1659x2212px. Remidio FOP fundus camera: 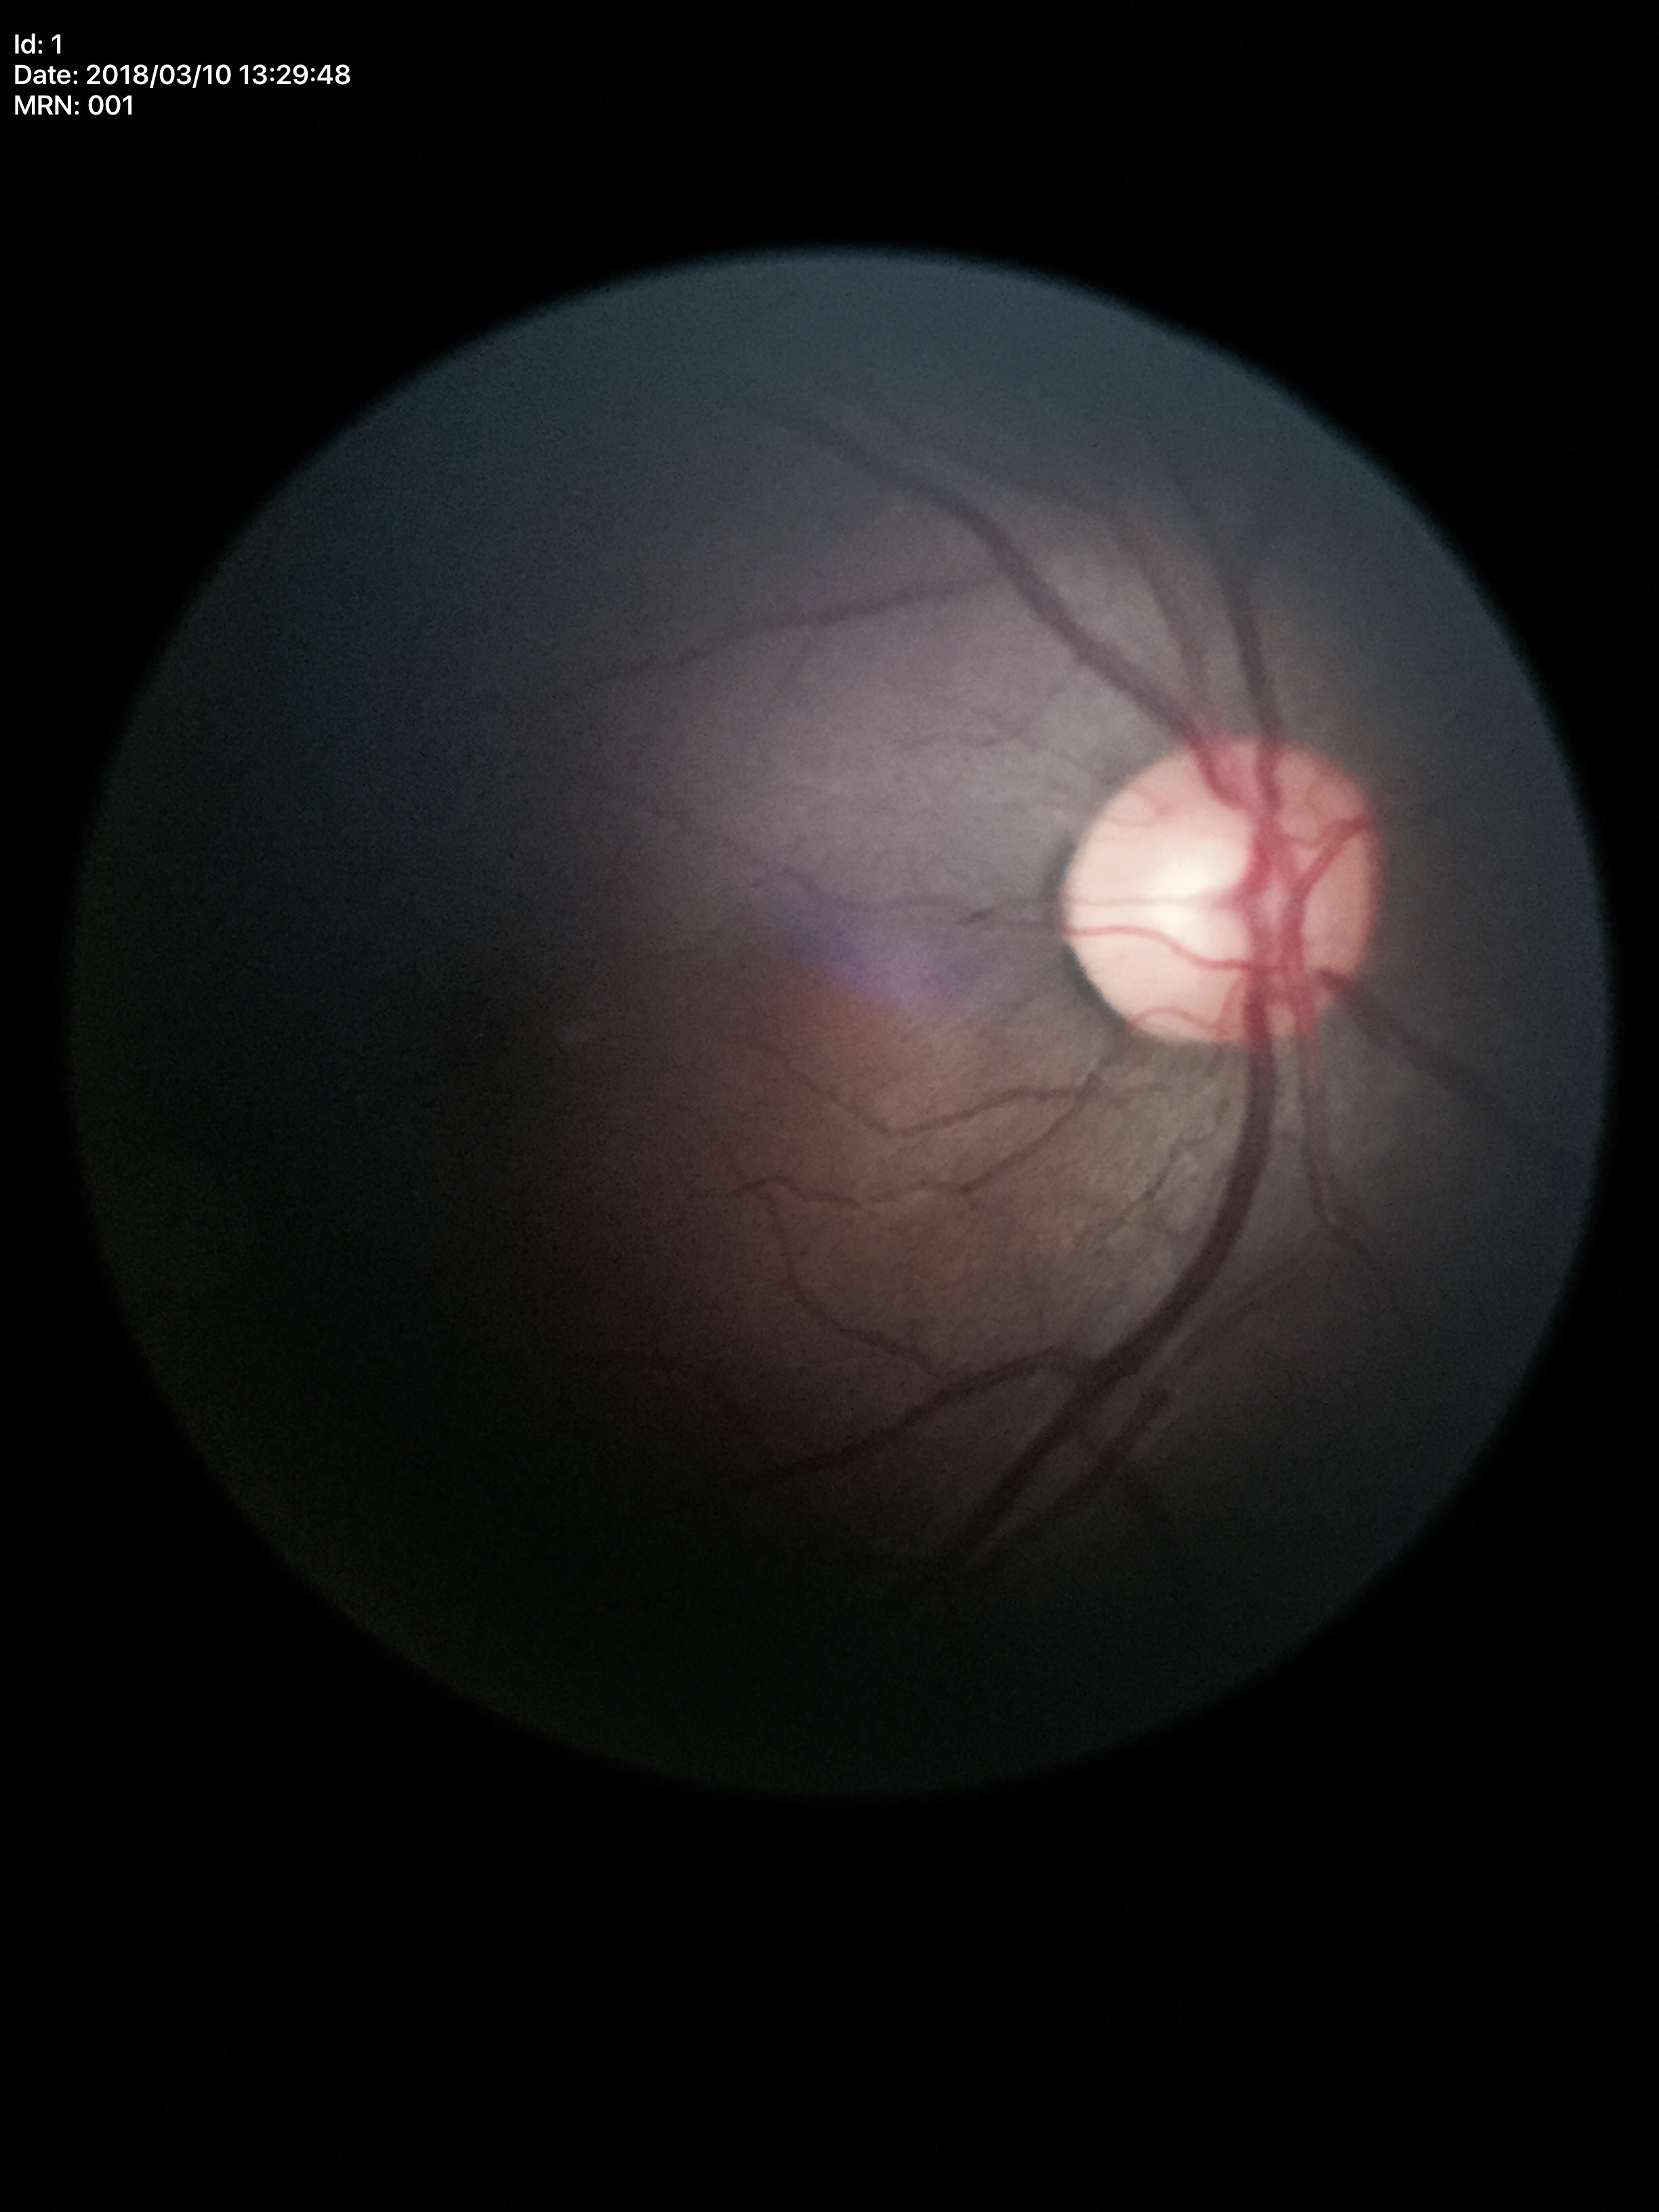

Glaucoma screening: not suspect | vertical cup-to-disc ratio: 0.59